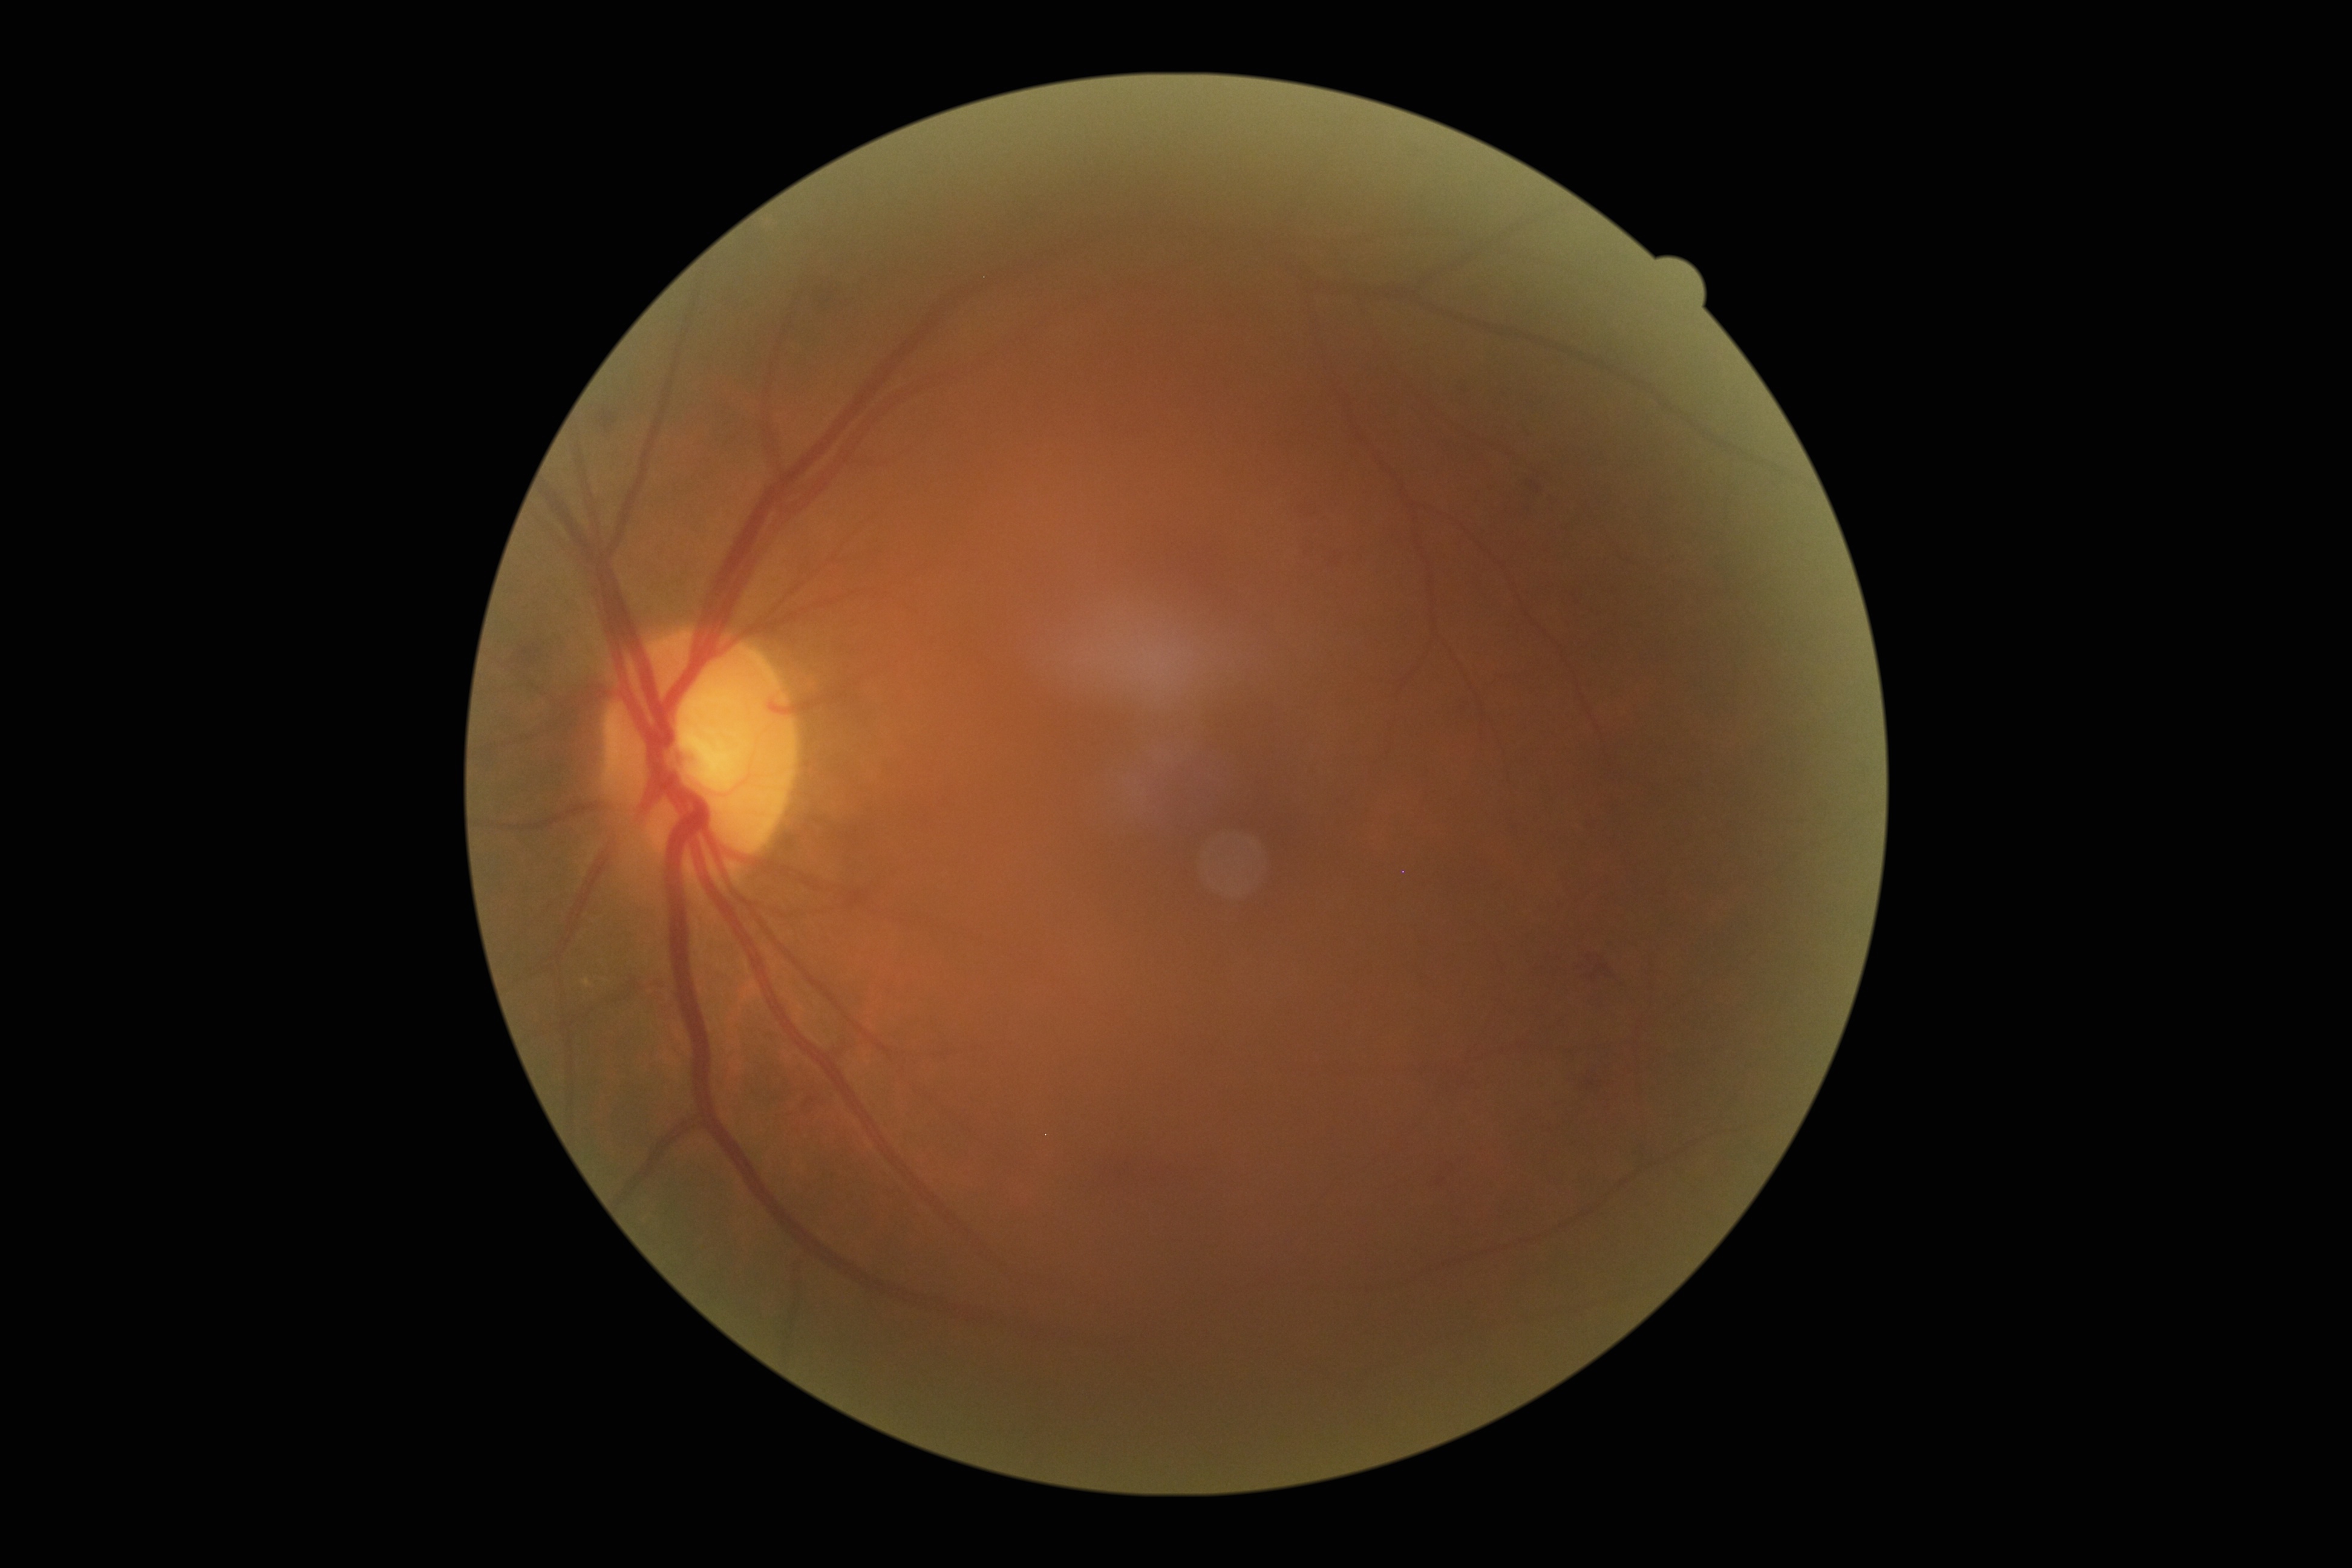 Diabetic retinopathy (DR): grade 2 (moderate NPDR).
Disease class: non-proliferative diabetic retinopathy.